Nonmydriatic; NIDEK AFC-230 fundus camera; 45 degree fundus photograph; fundus photo; diabetic retinopathy graded by the modified Davis classification
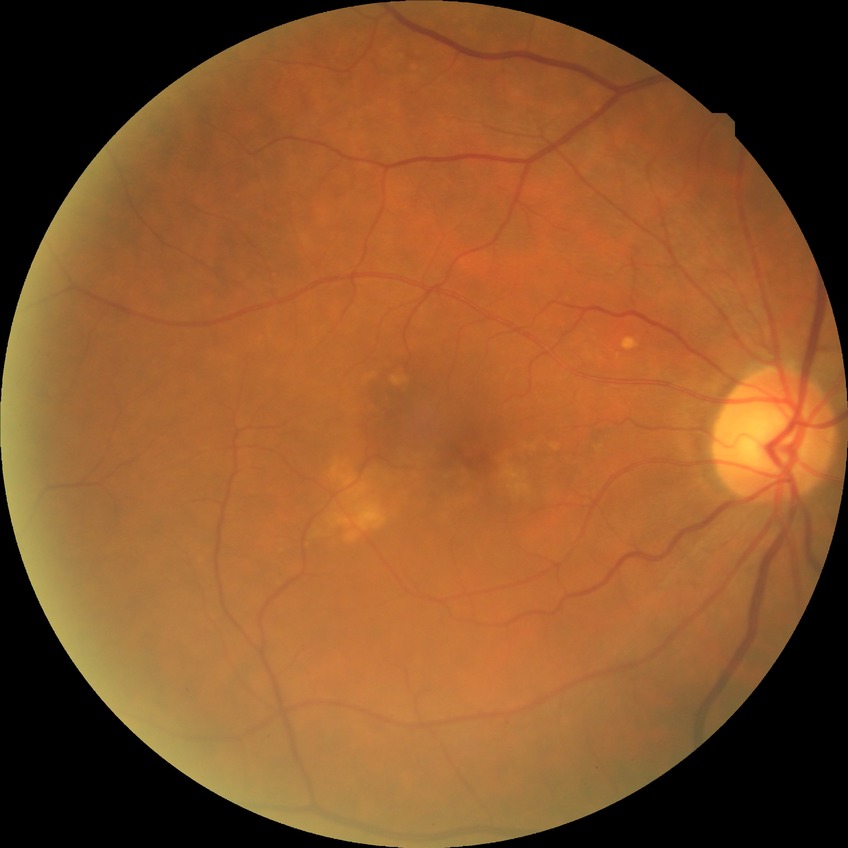
Davis DR grade=NDR.